Retinal fundus photograph:
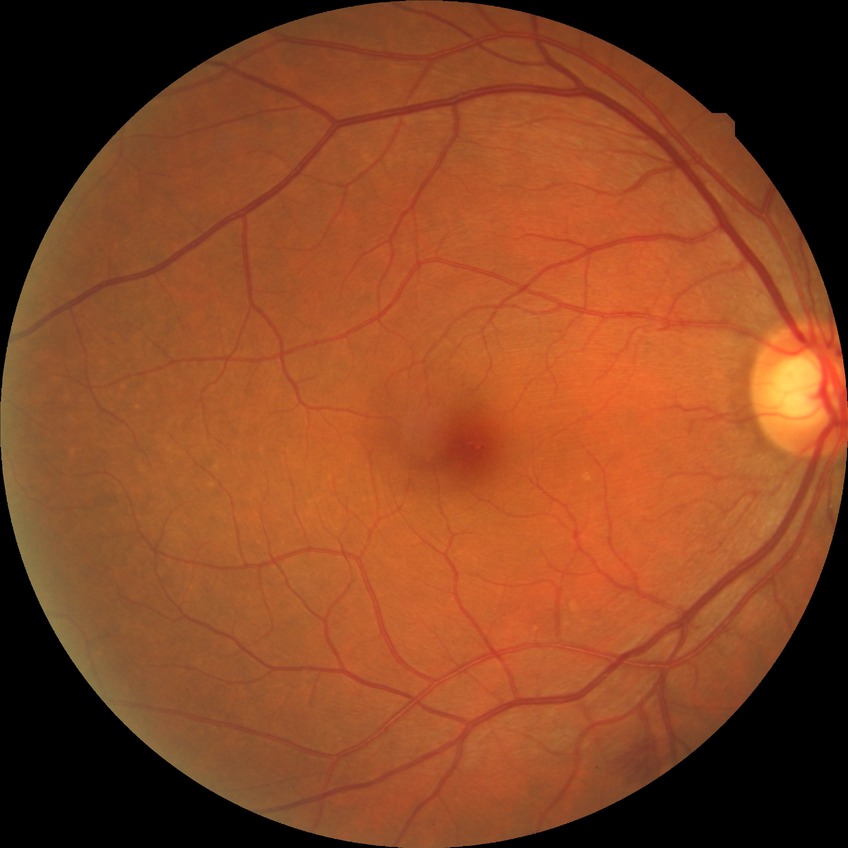

Diabetic retinopathy (DR) is NDR (no diabetic retinopathy).